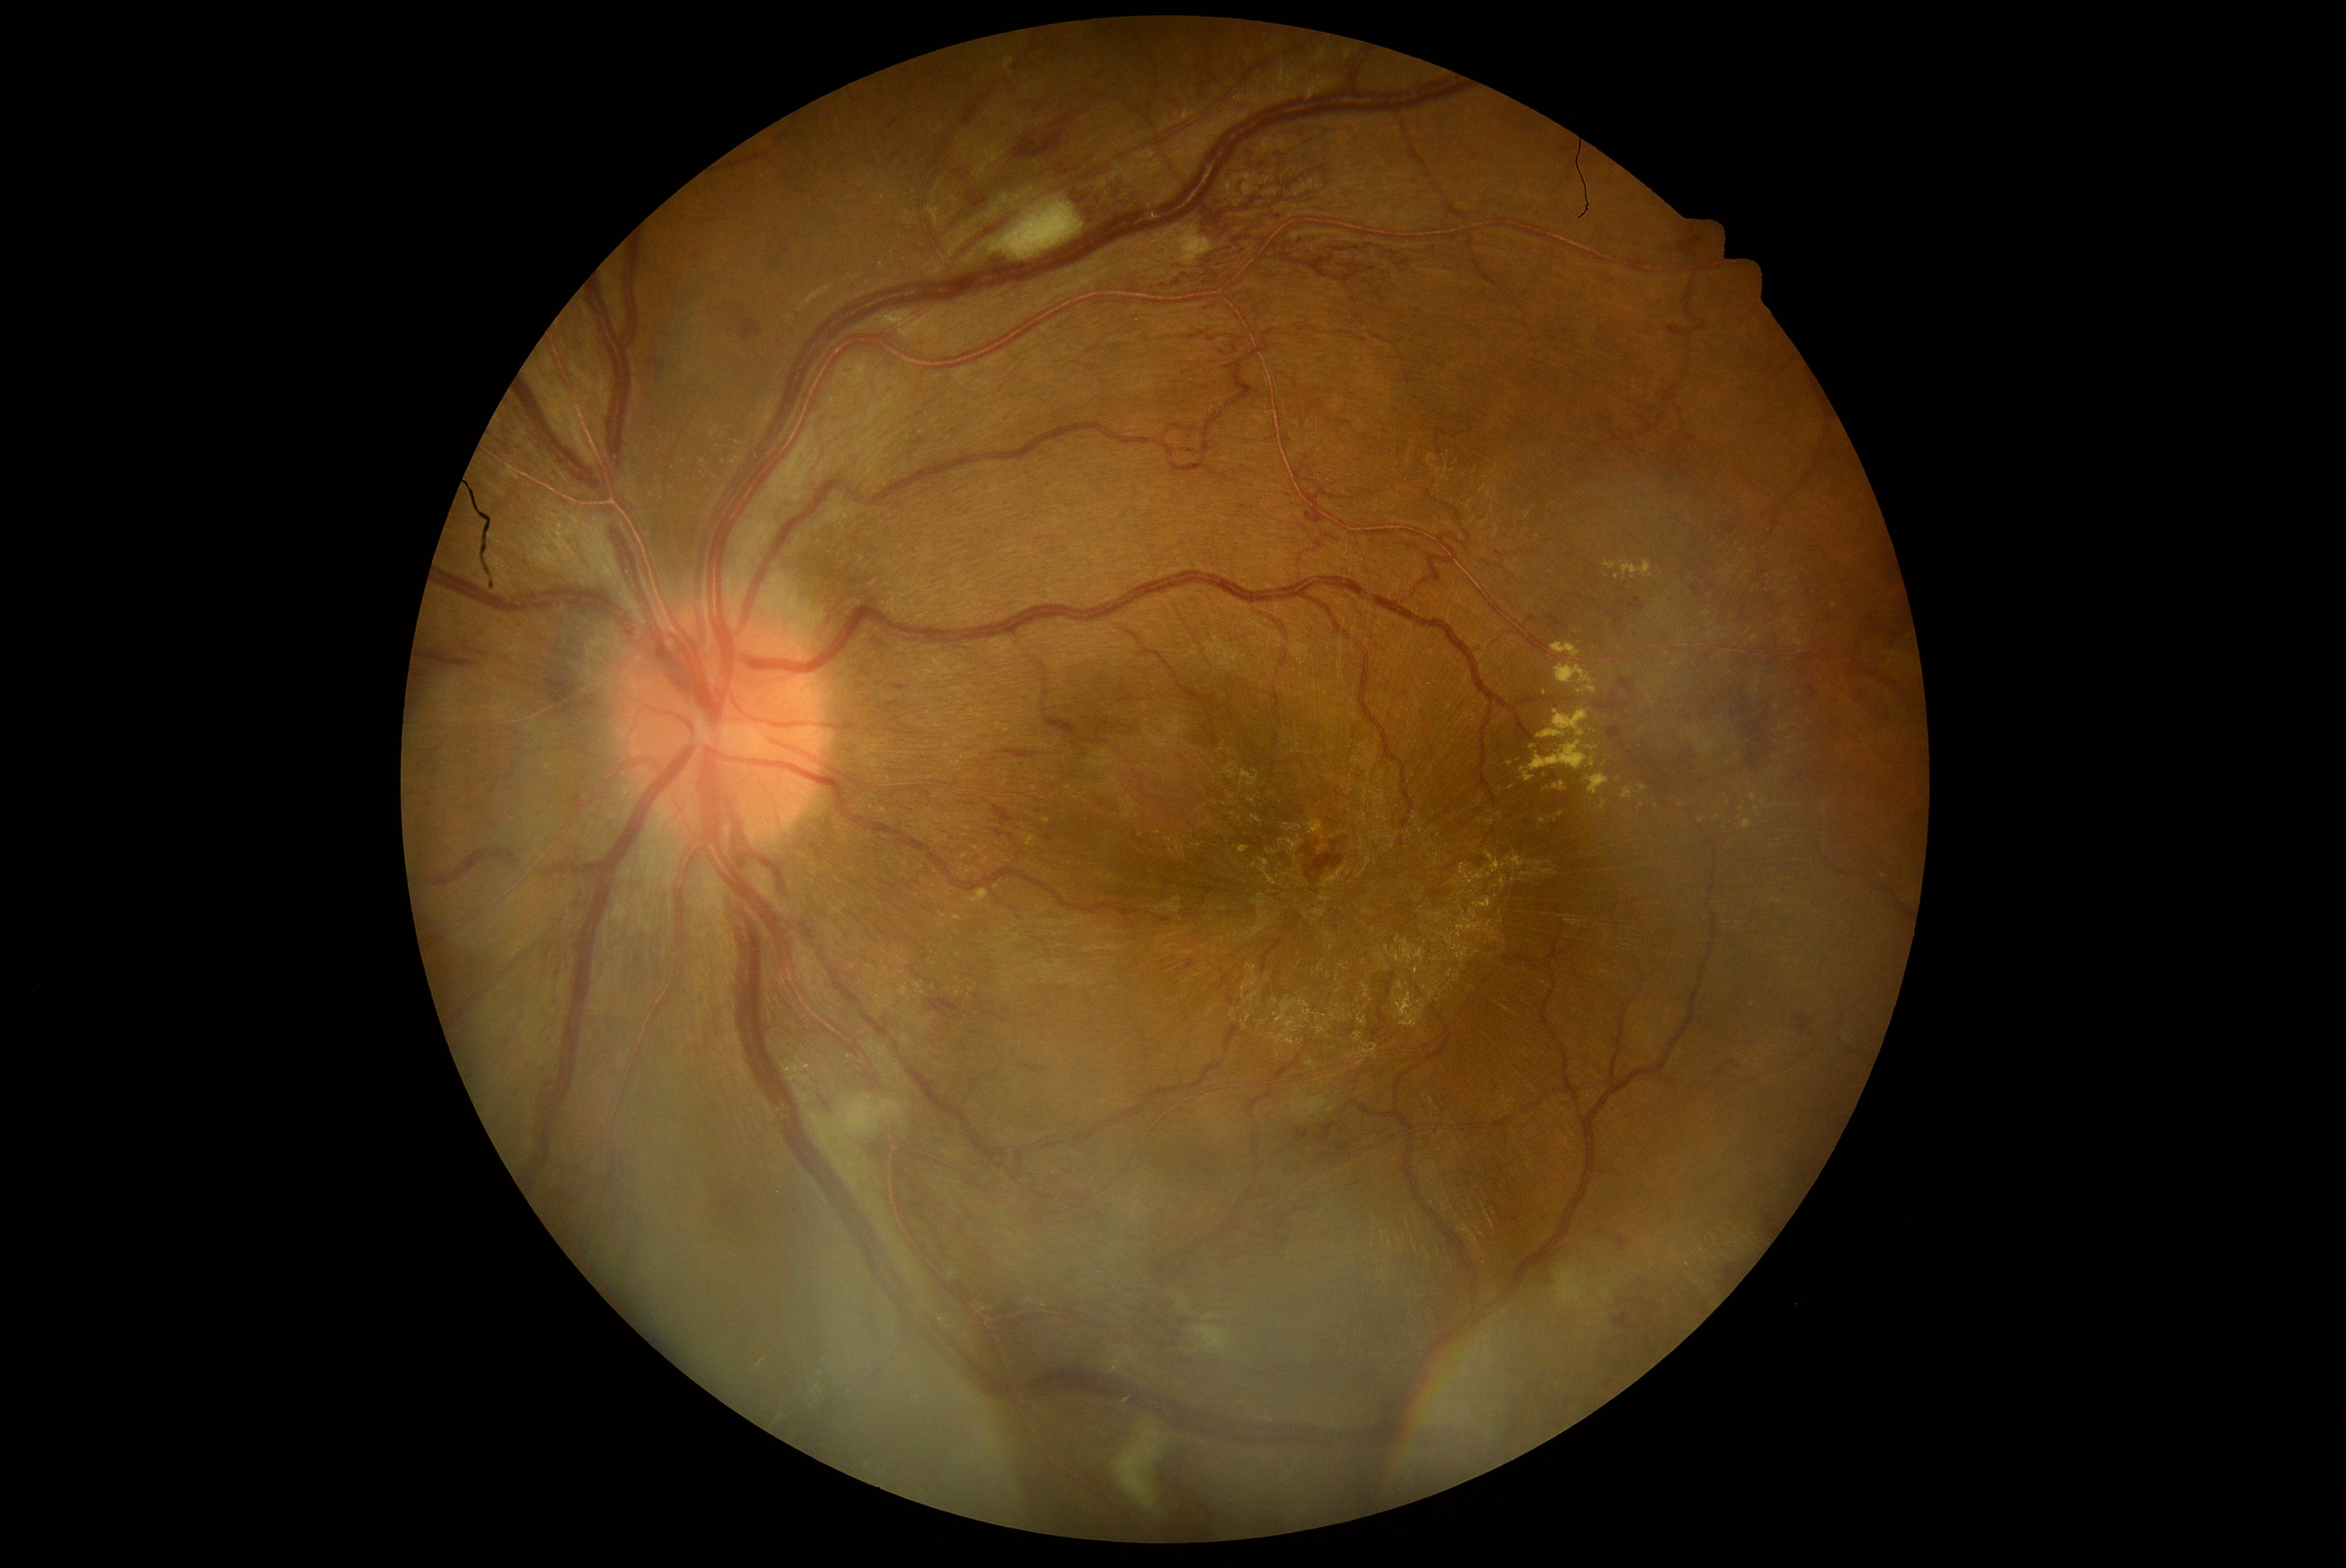 Diabetic retinopathy is 3 — more than 20 intraretinal hemorrhages in each of 4 quadrants, definite venous beading in 2 or more quadrants, or prominent intraretinal microvascular abnormalities in 1 or more quadrants, with no signs of proliferative retinopathy
A subset of detected lesions:
microaneurysms: absent
hard exudates (continued): (x1=1553, y1=811, x2=1563, y2=821) | (x1=1560, y1=783, x2=1566, y2=791) | (x1=1153, y1=227, x2=1216, y2=266) | (x1=1751, y1=793, x2=1757, y2=802) | (x1=1602, y1=800, x2=1607, y2=810) | (x1=1538, y1=711, x2=1589, y2=739) | (x1=1586, y1=774, x2=1610, y2=796) | (x1=804, y1=285, x2=837, y2=308) | (x1=1522, y1=768, x2=1534, y2=782) | (x1=1740, y1=819, x2=1754, y2=830)
Additional small hard exudates near [x=1513, y=787] | [x=1743, y=807] | [x=1772, y=806] | [x=1617, y=577] | [x=1683, y=805] | [x=1763, y=802]
soft exudates (continued): (x1=990, y1=197, x2=1084, y2=261) | (x1=1556, y1=1265, x2=1589, y2=1307) | (x1=1113, y1=1421, x2=1166, y2=1514) | (x1=1194, y1=1326, x2=1229, y2=1351) | (x1=808, y1=1094, x2=906, y2=1147)
Additional small soft exudates near [x=908, y=1106]
hemorrhages (continued): (x1=965, y1=189, x2=995, y2=212) | (x1=1789, y1=1011, x2=1817, y2=1040) | (x1=1668, y1=325, x2=1688, y2=343) | (x1=1315, y1=1123, x2=1342, y2=1144) | (x1=895, y1=680, x2=910, y2=691) | (x1=424, y1=797, x2=438, y2=811) | (x1=1619, y1=680, x2=1636, y2=695) | (x1=656, y1=363, x2=666, y2=368) | (x1=1859, y1=692, x2=1867, y2=702) | (x1=957, y1=208, x2=968, y2=220) | (x1=1155, y1=1440, x2=1249, y2=1531) | (x1=1870, y1=597, x2=1906, y2=655) | (x1=1610, y1=1233, x2=1635, y2=1257) | (x1=1647, y1=760, x2=1660, y2=769) | (x1=1876, y1=710, x2=1897, y2=731)
Additional small hemorrhages near [x=1704, y=715] | [x=1374, y=1069] | [x=940, y=1029] | [x=1707, y=706] | [x=969, y=186]